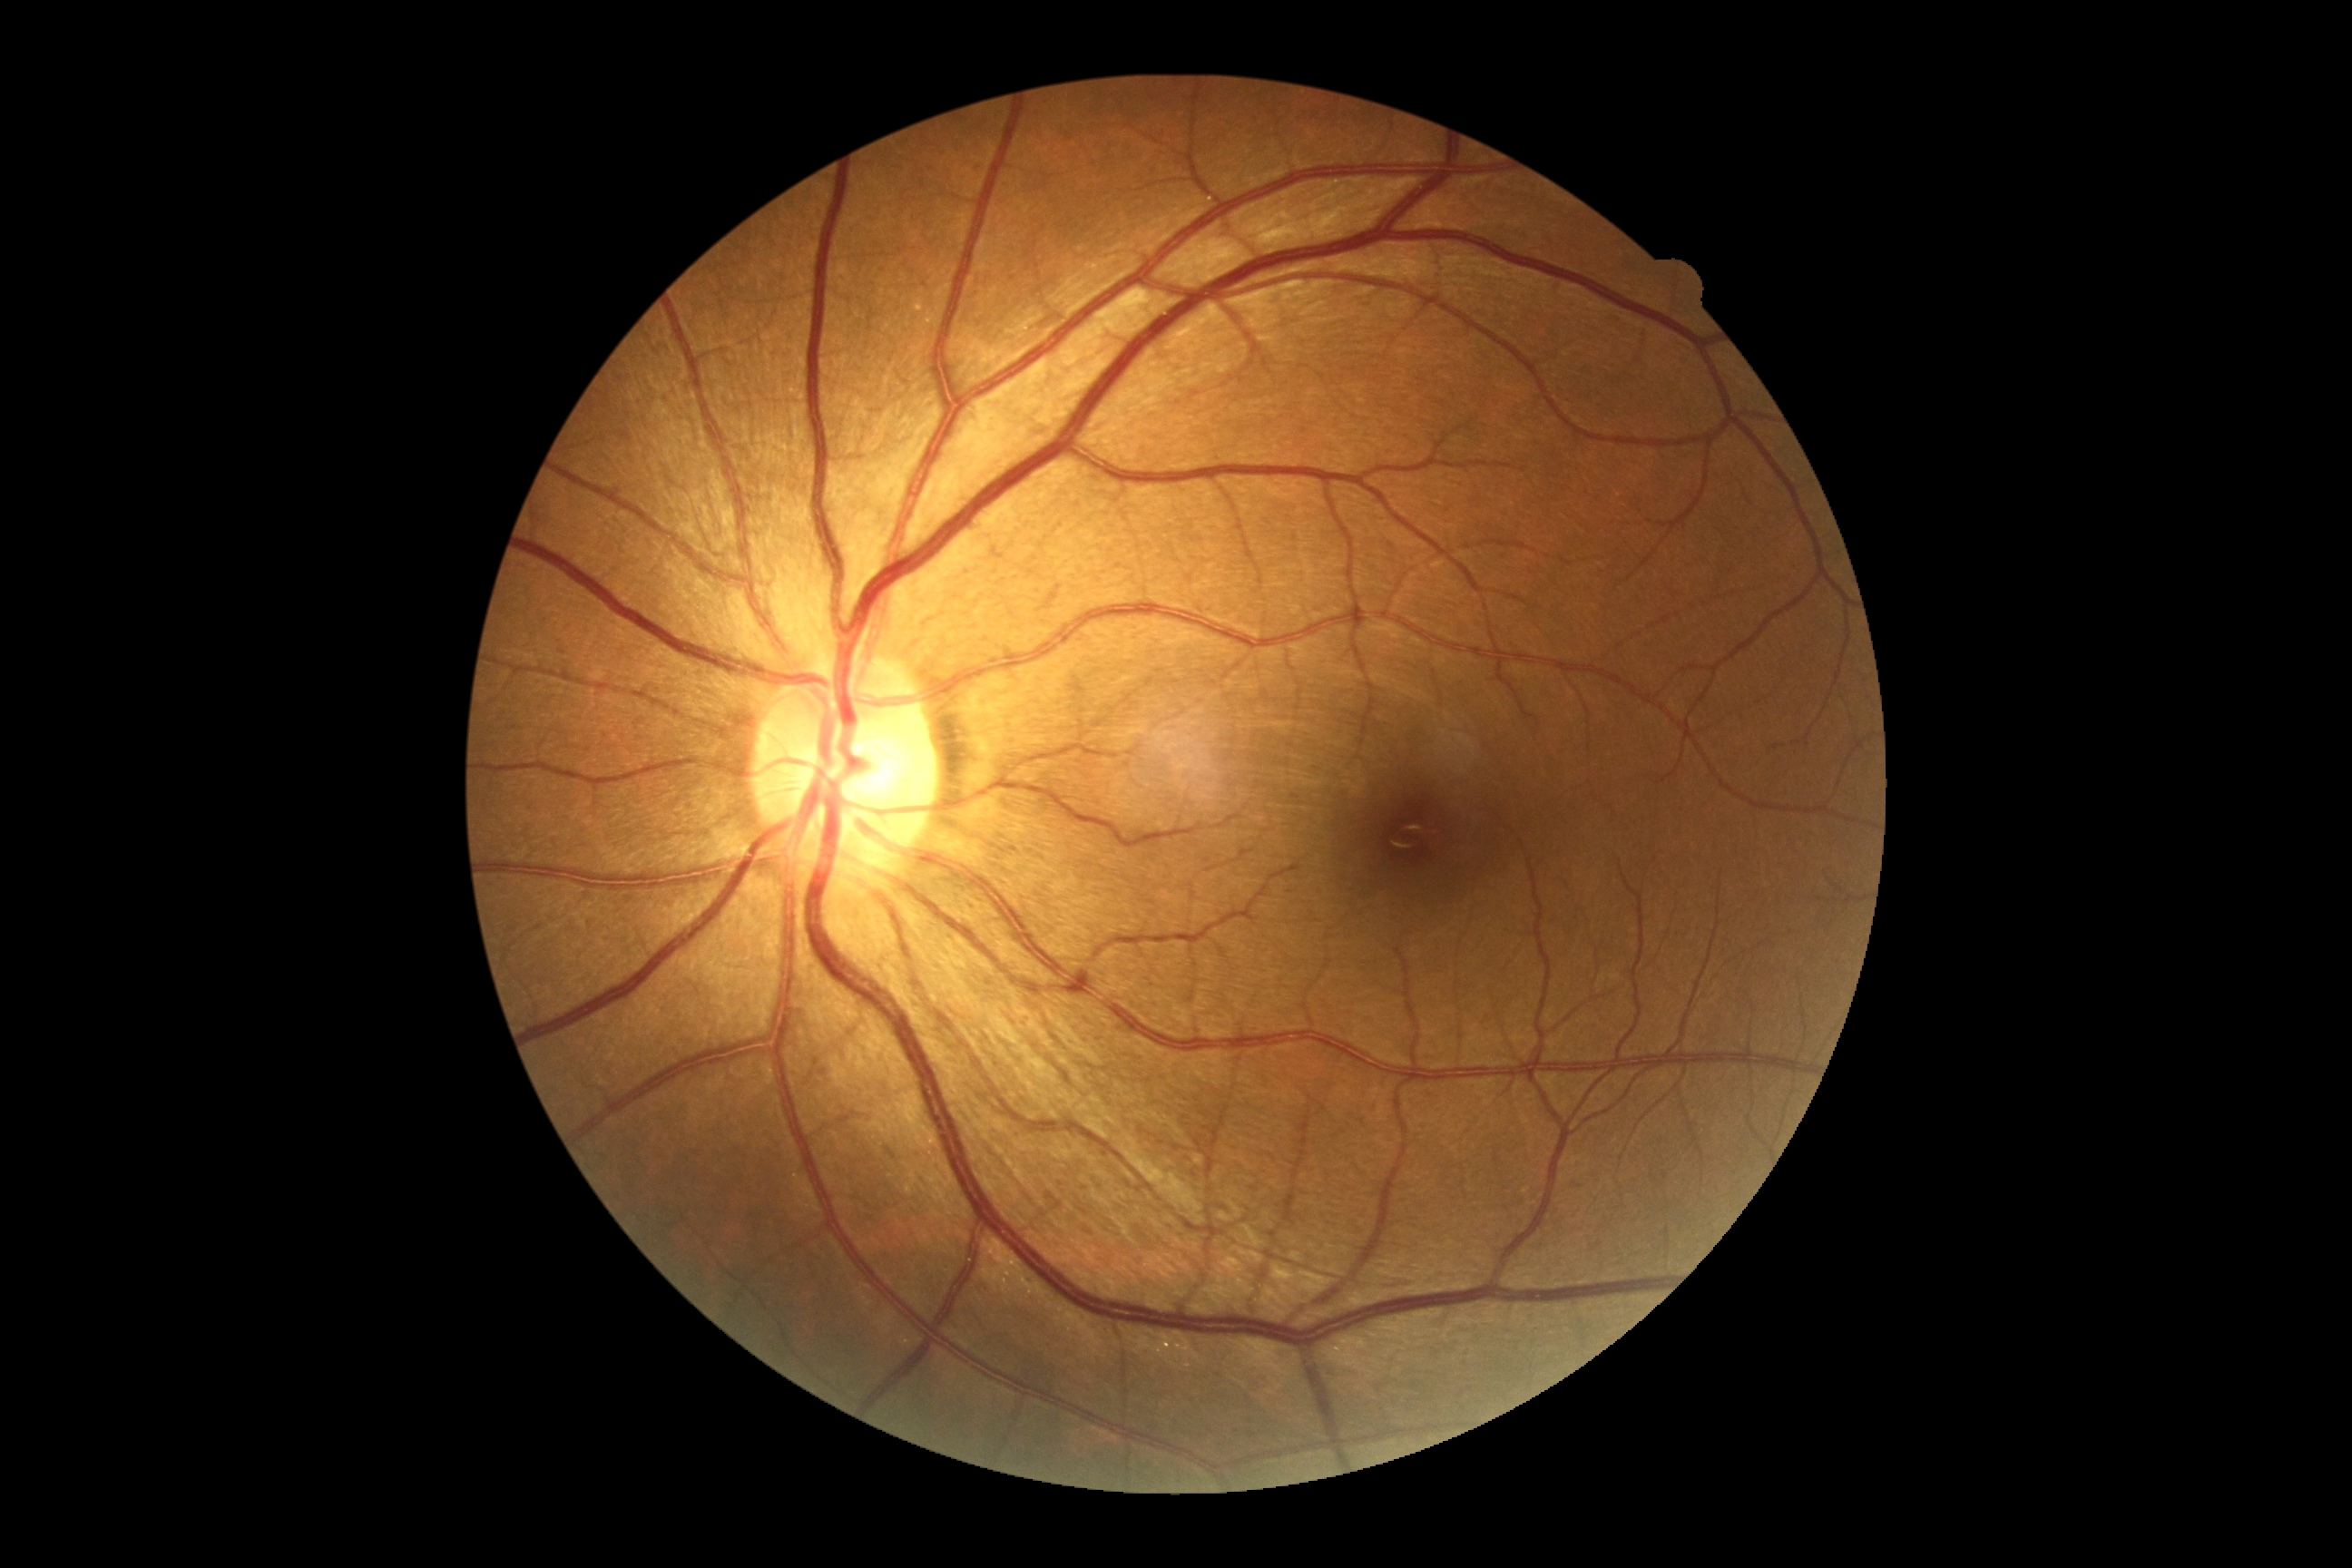

  dr_grade: 0/4